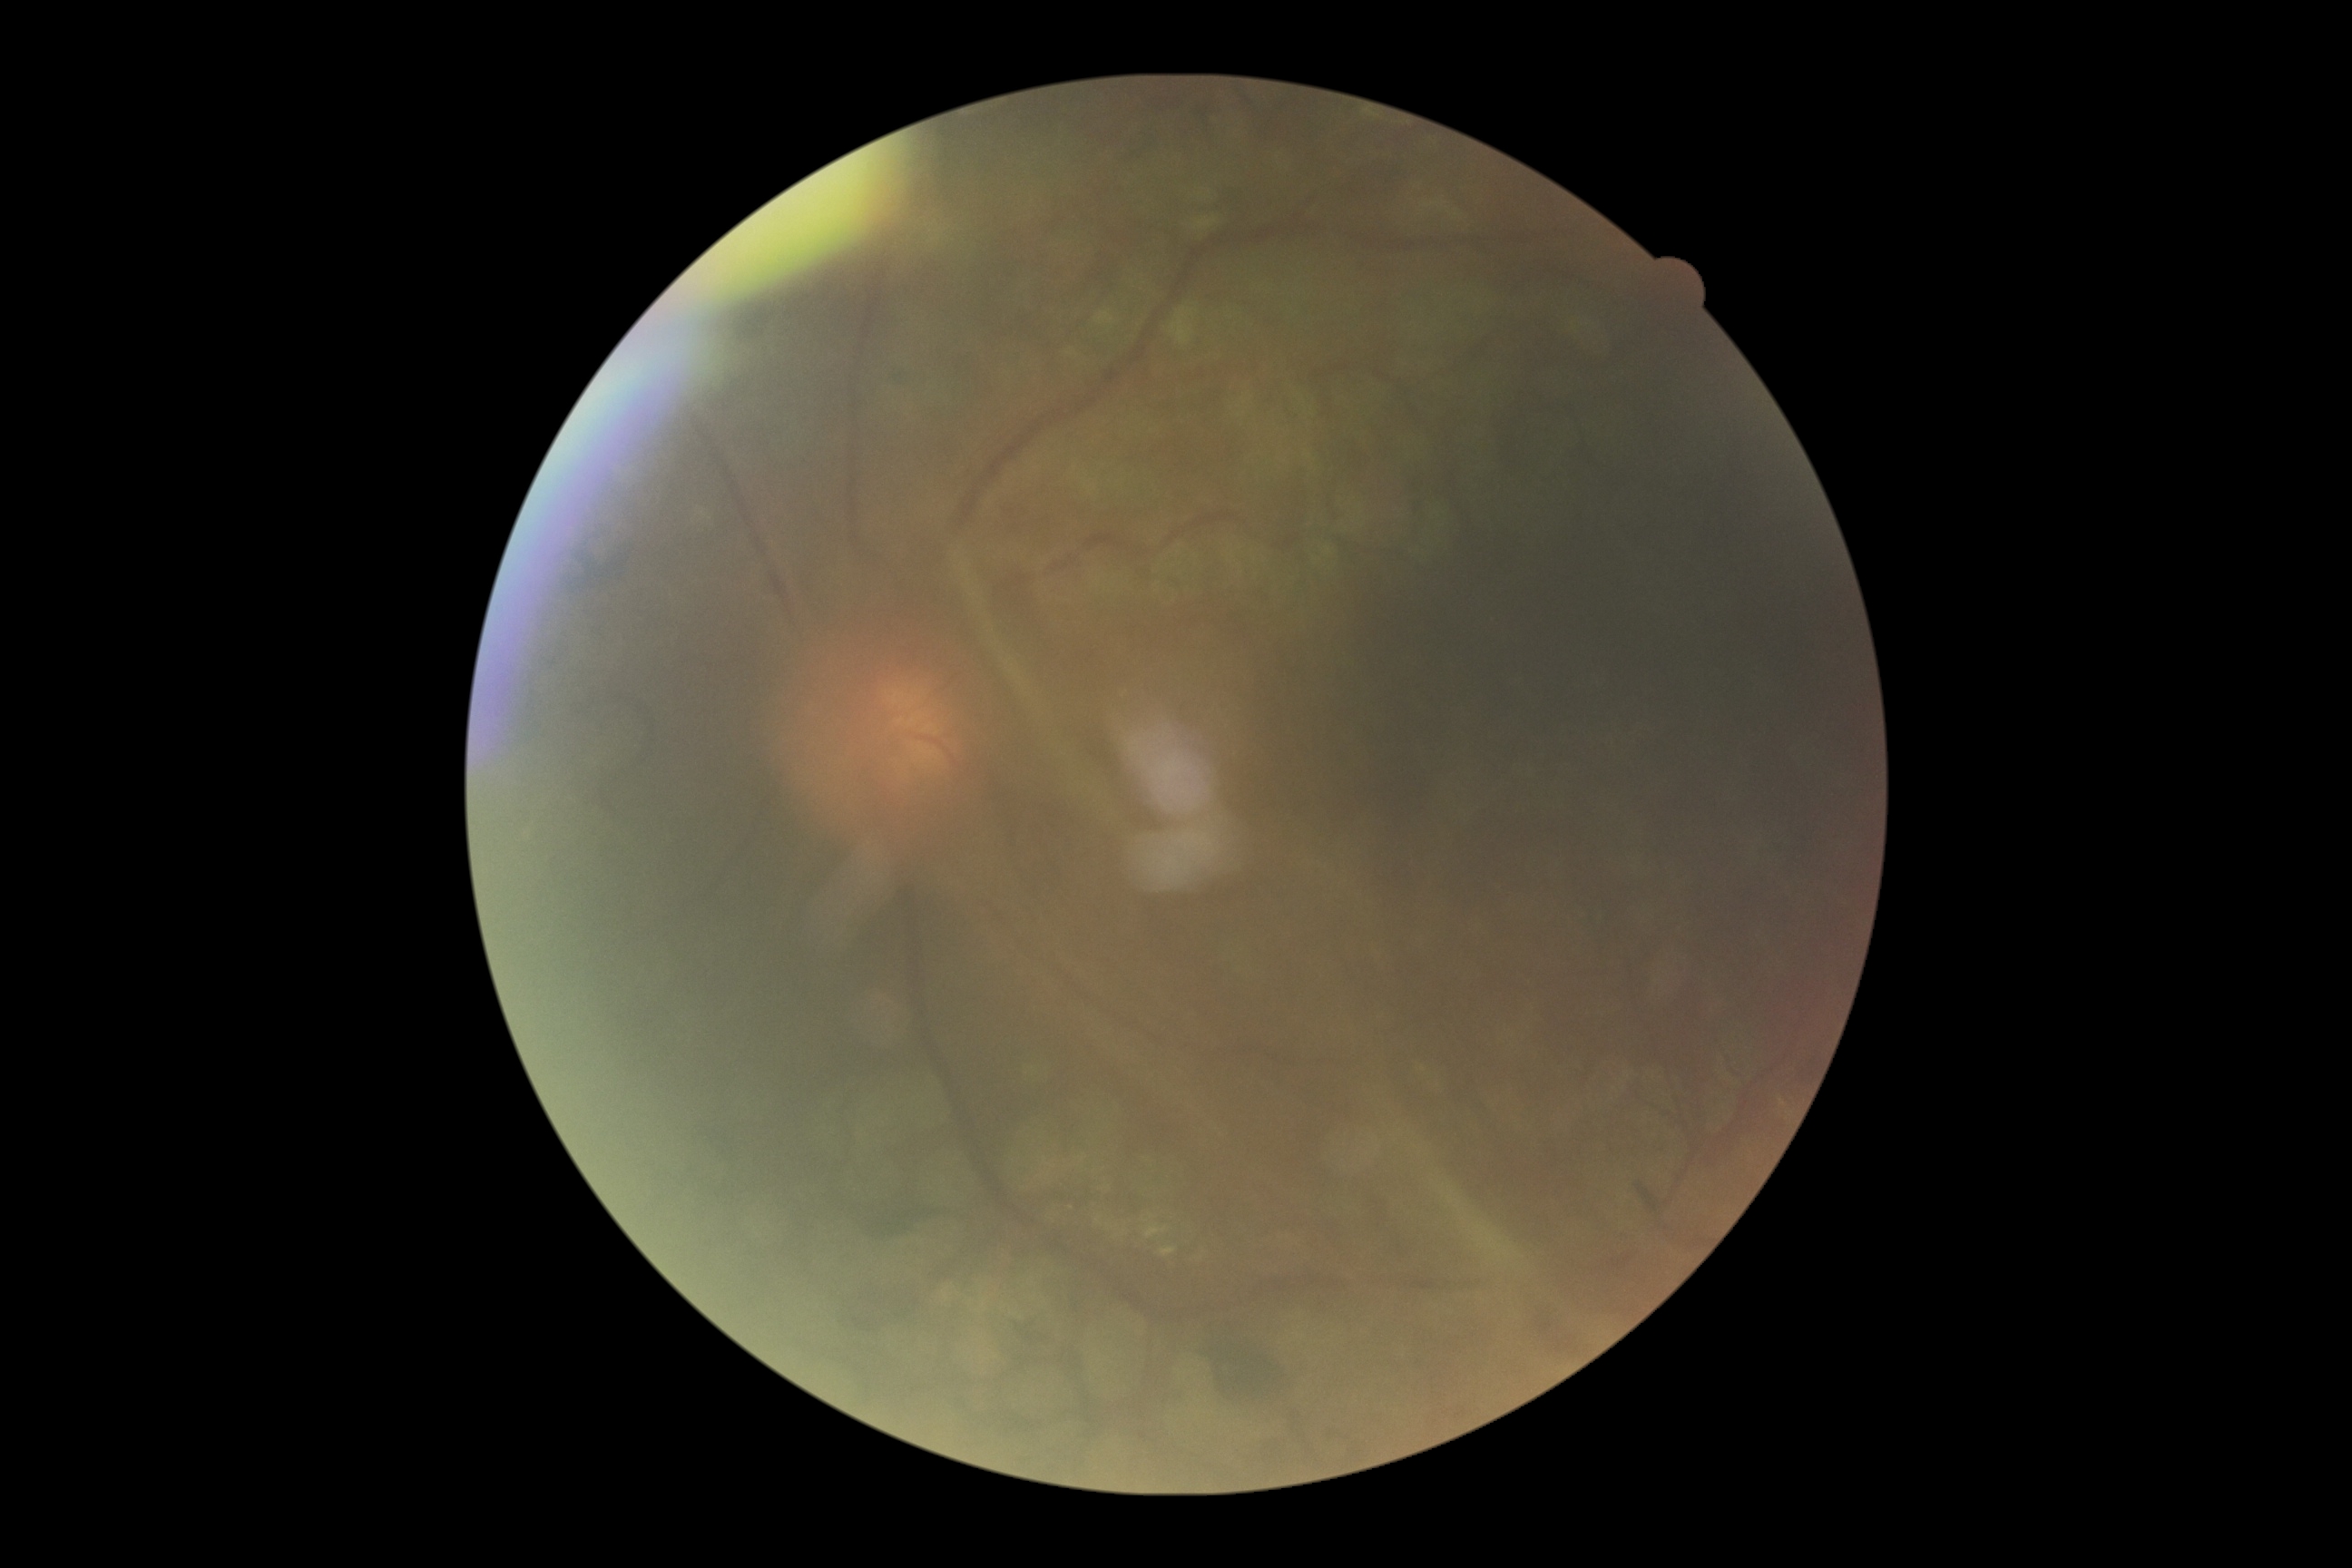 DR: grade 4 (PDR).
DR class: proliferative diabetic retinopathy.